Wide-field fundus image from infant ROP screening:
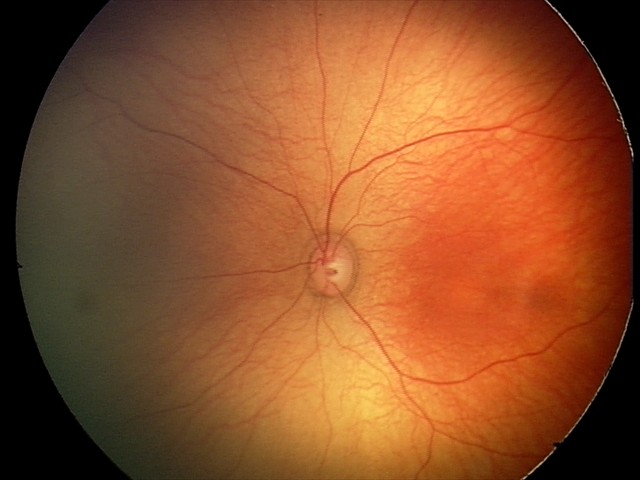

Screening diagnosis: physiological appearance.